2048x1536; fundus photo: 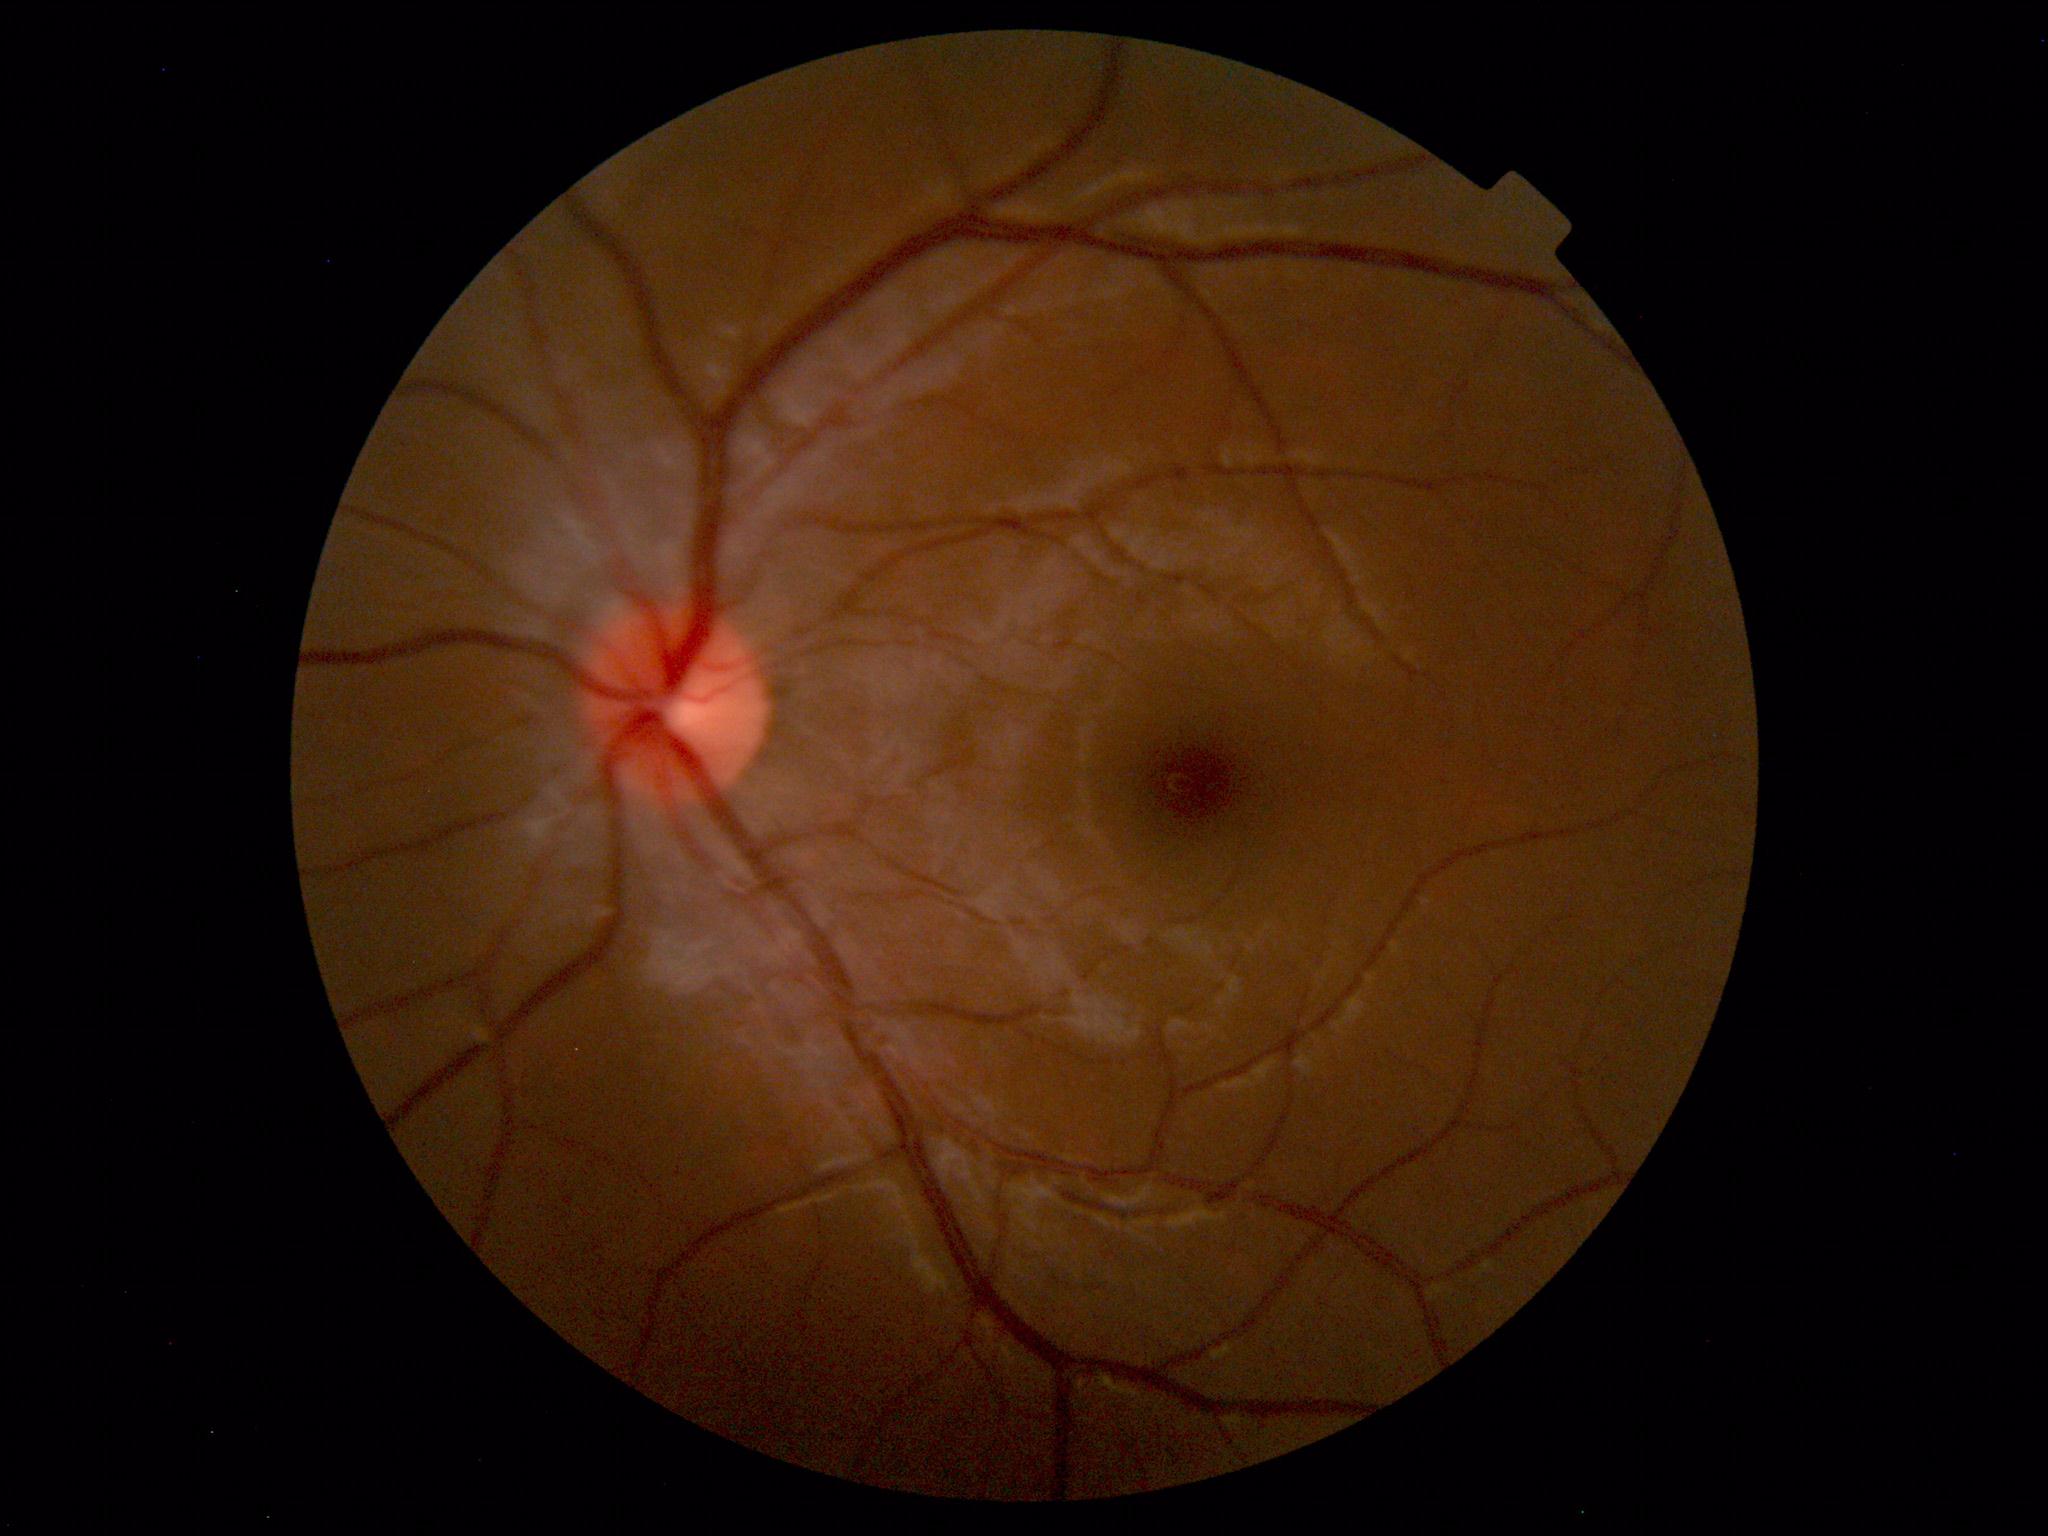
Diagnosis: normal.